240 x 240 pixels:
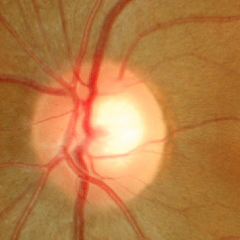
There is evidence of no glaucomatous optic neuropathy.